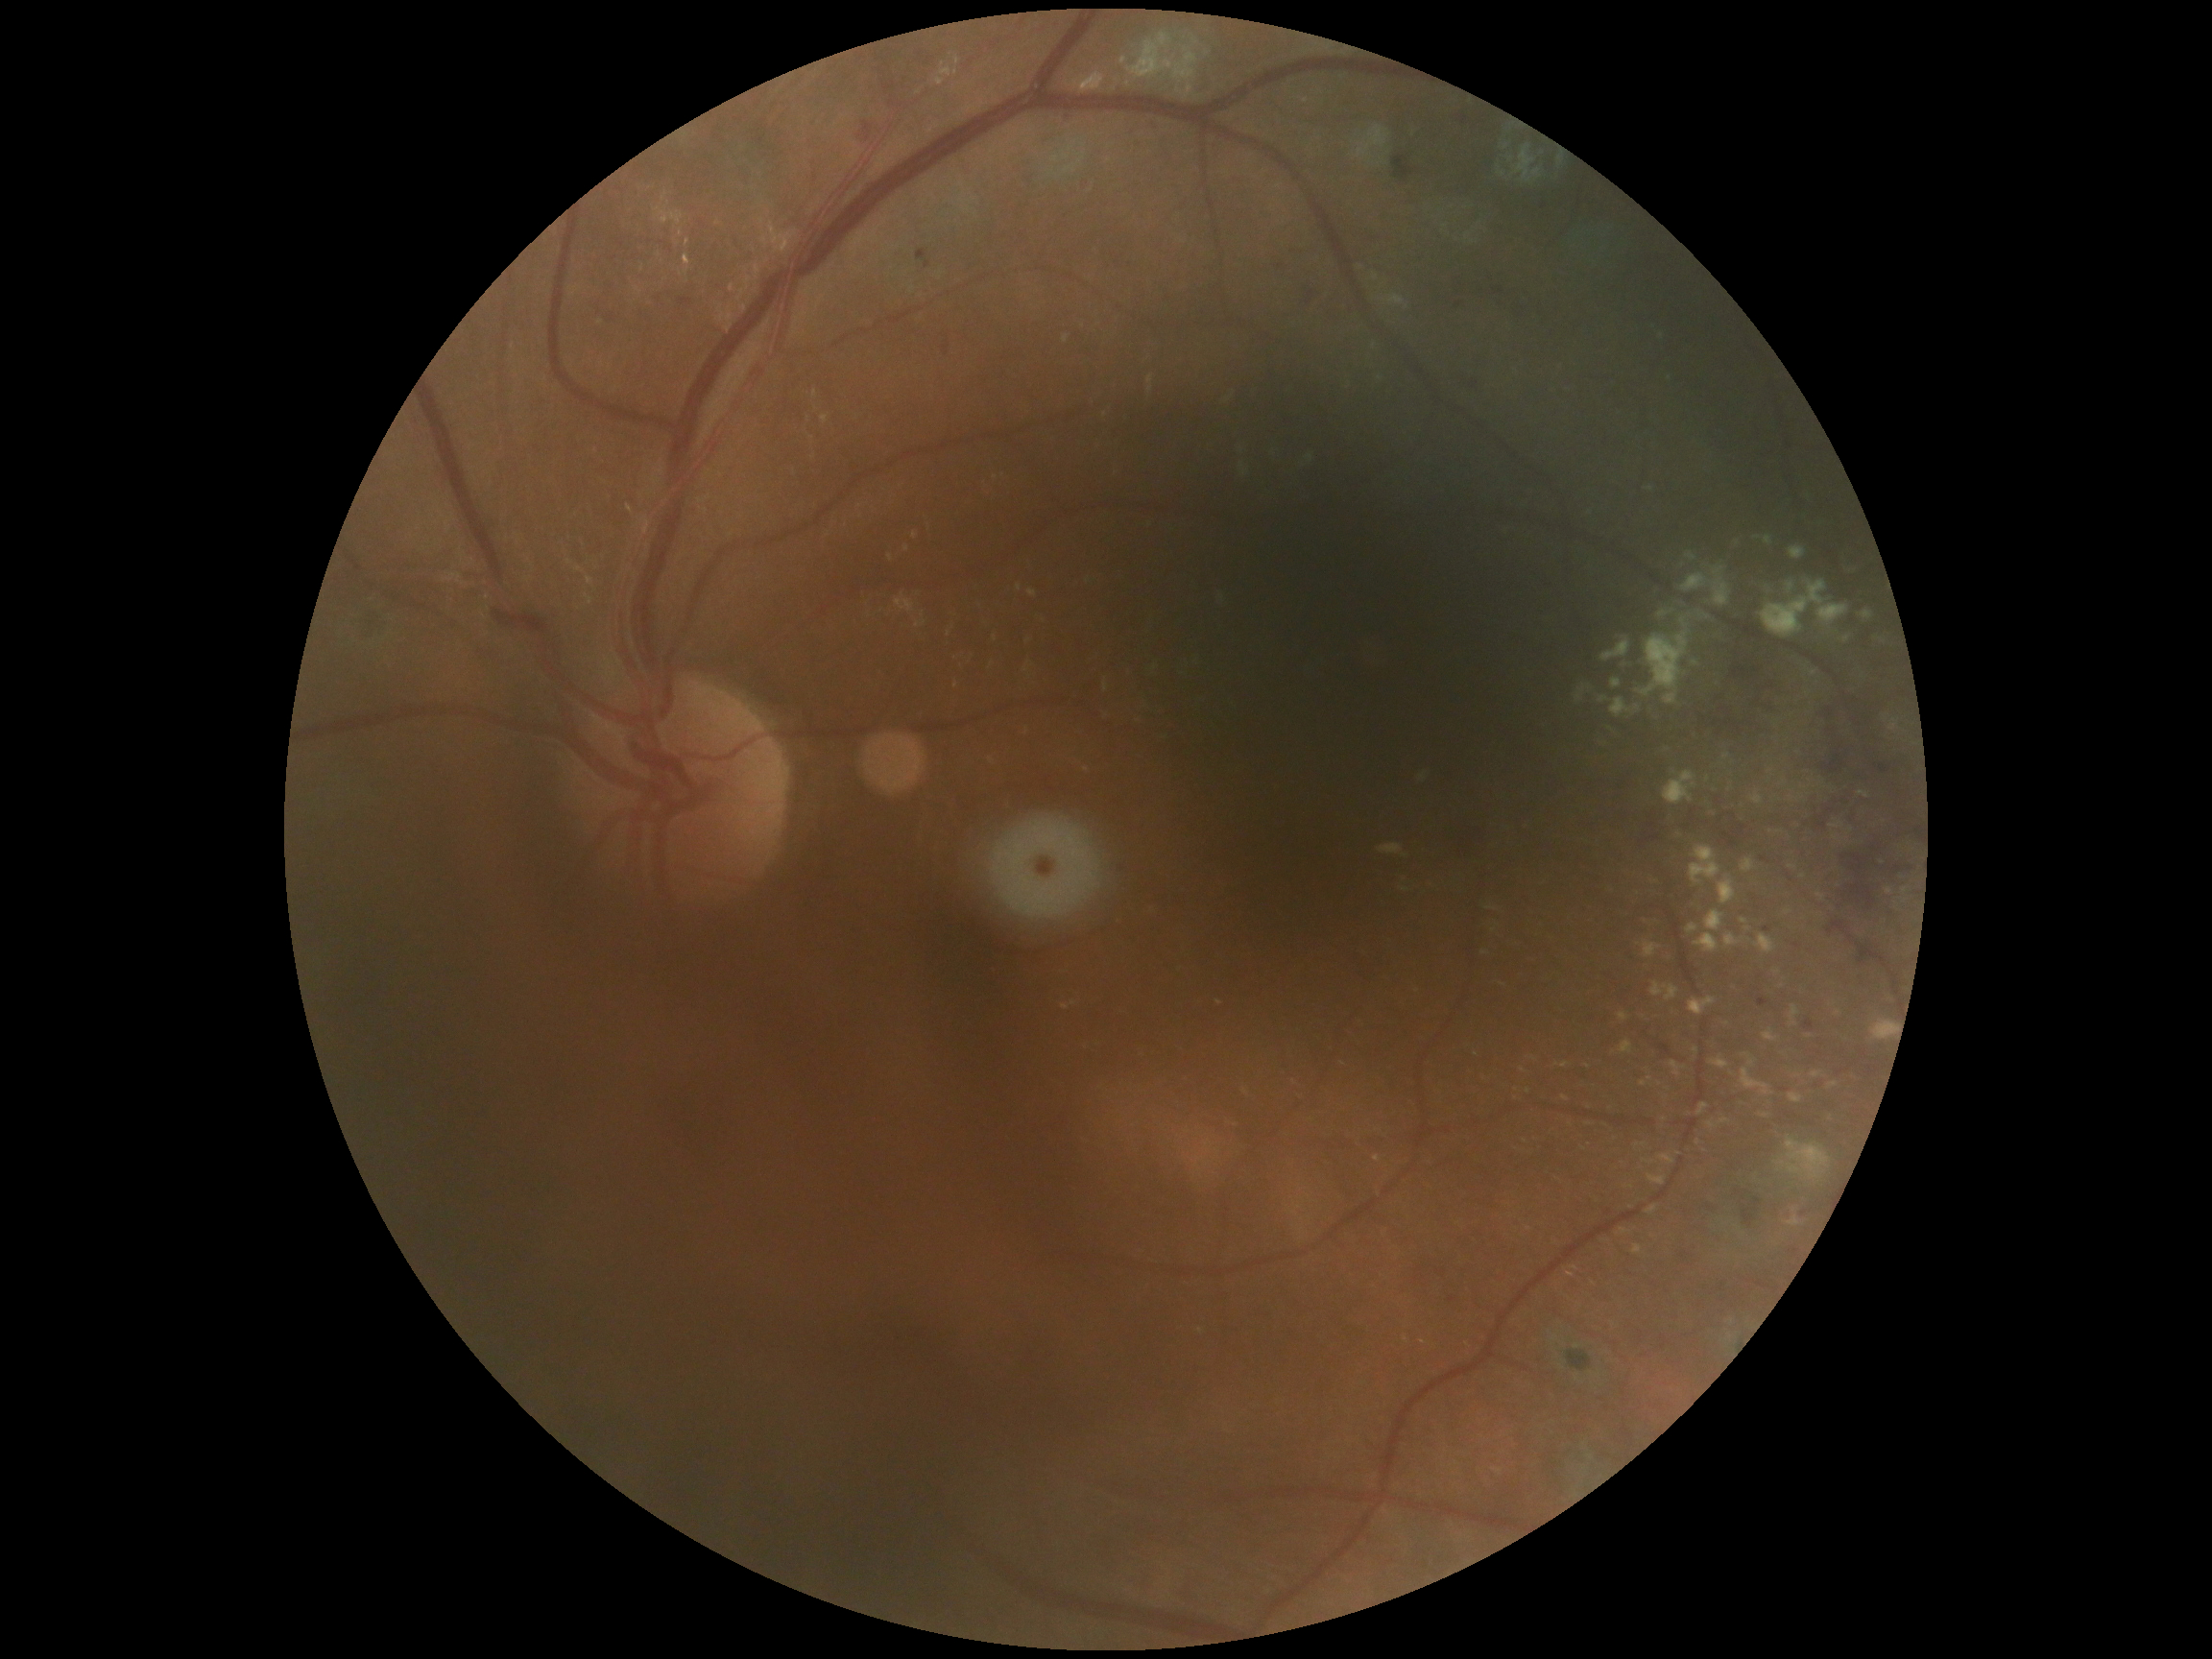

Diabetic retinopathy (DR) is moderate non-proliferative diabetic retinopathy (grade 2).